640 x 480 pixels · RetCam wide-field infant fundus image · Clarity RetCam 3, 130° FOV.
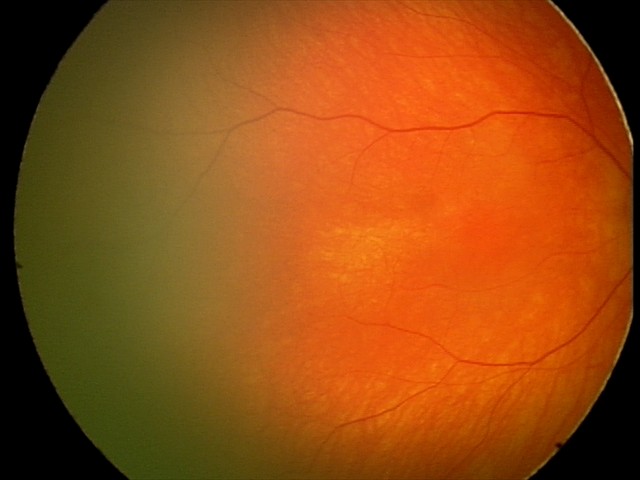

Examination with physiological retinal findings.